CFP:
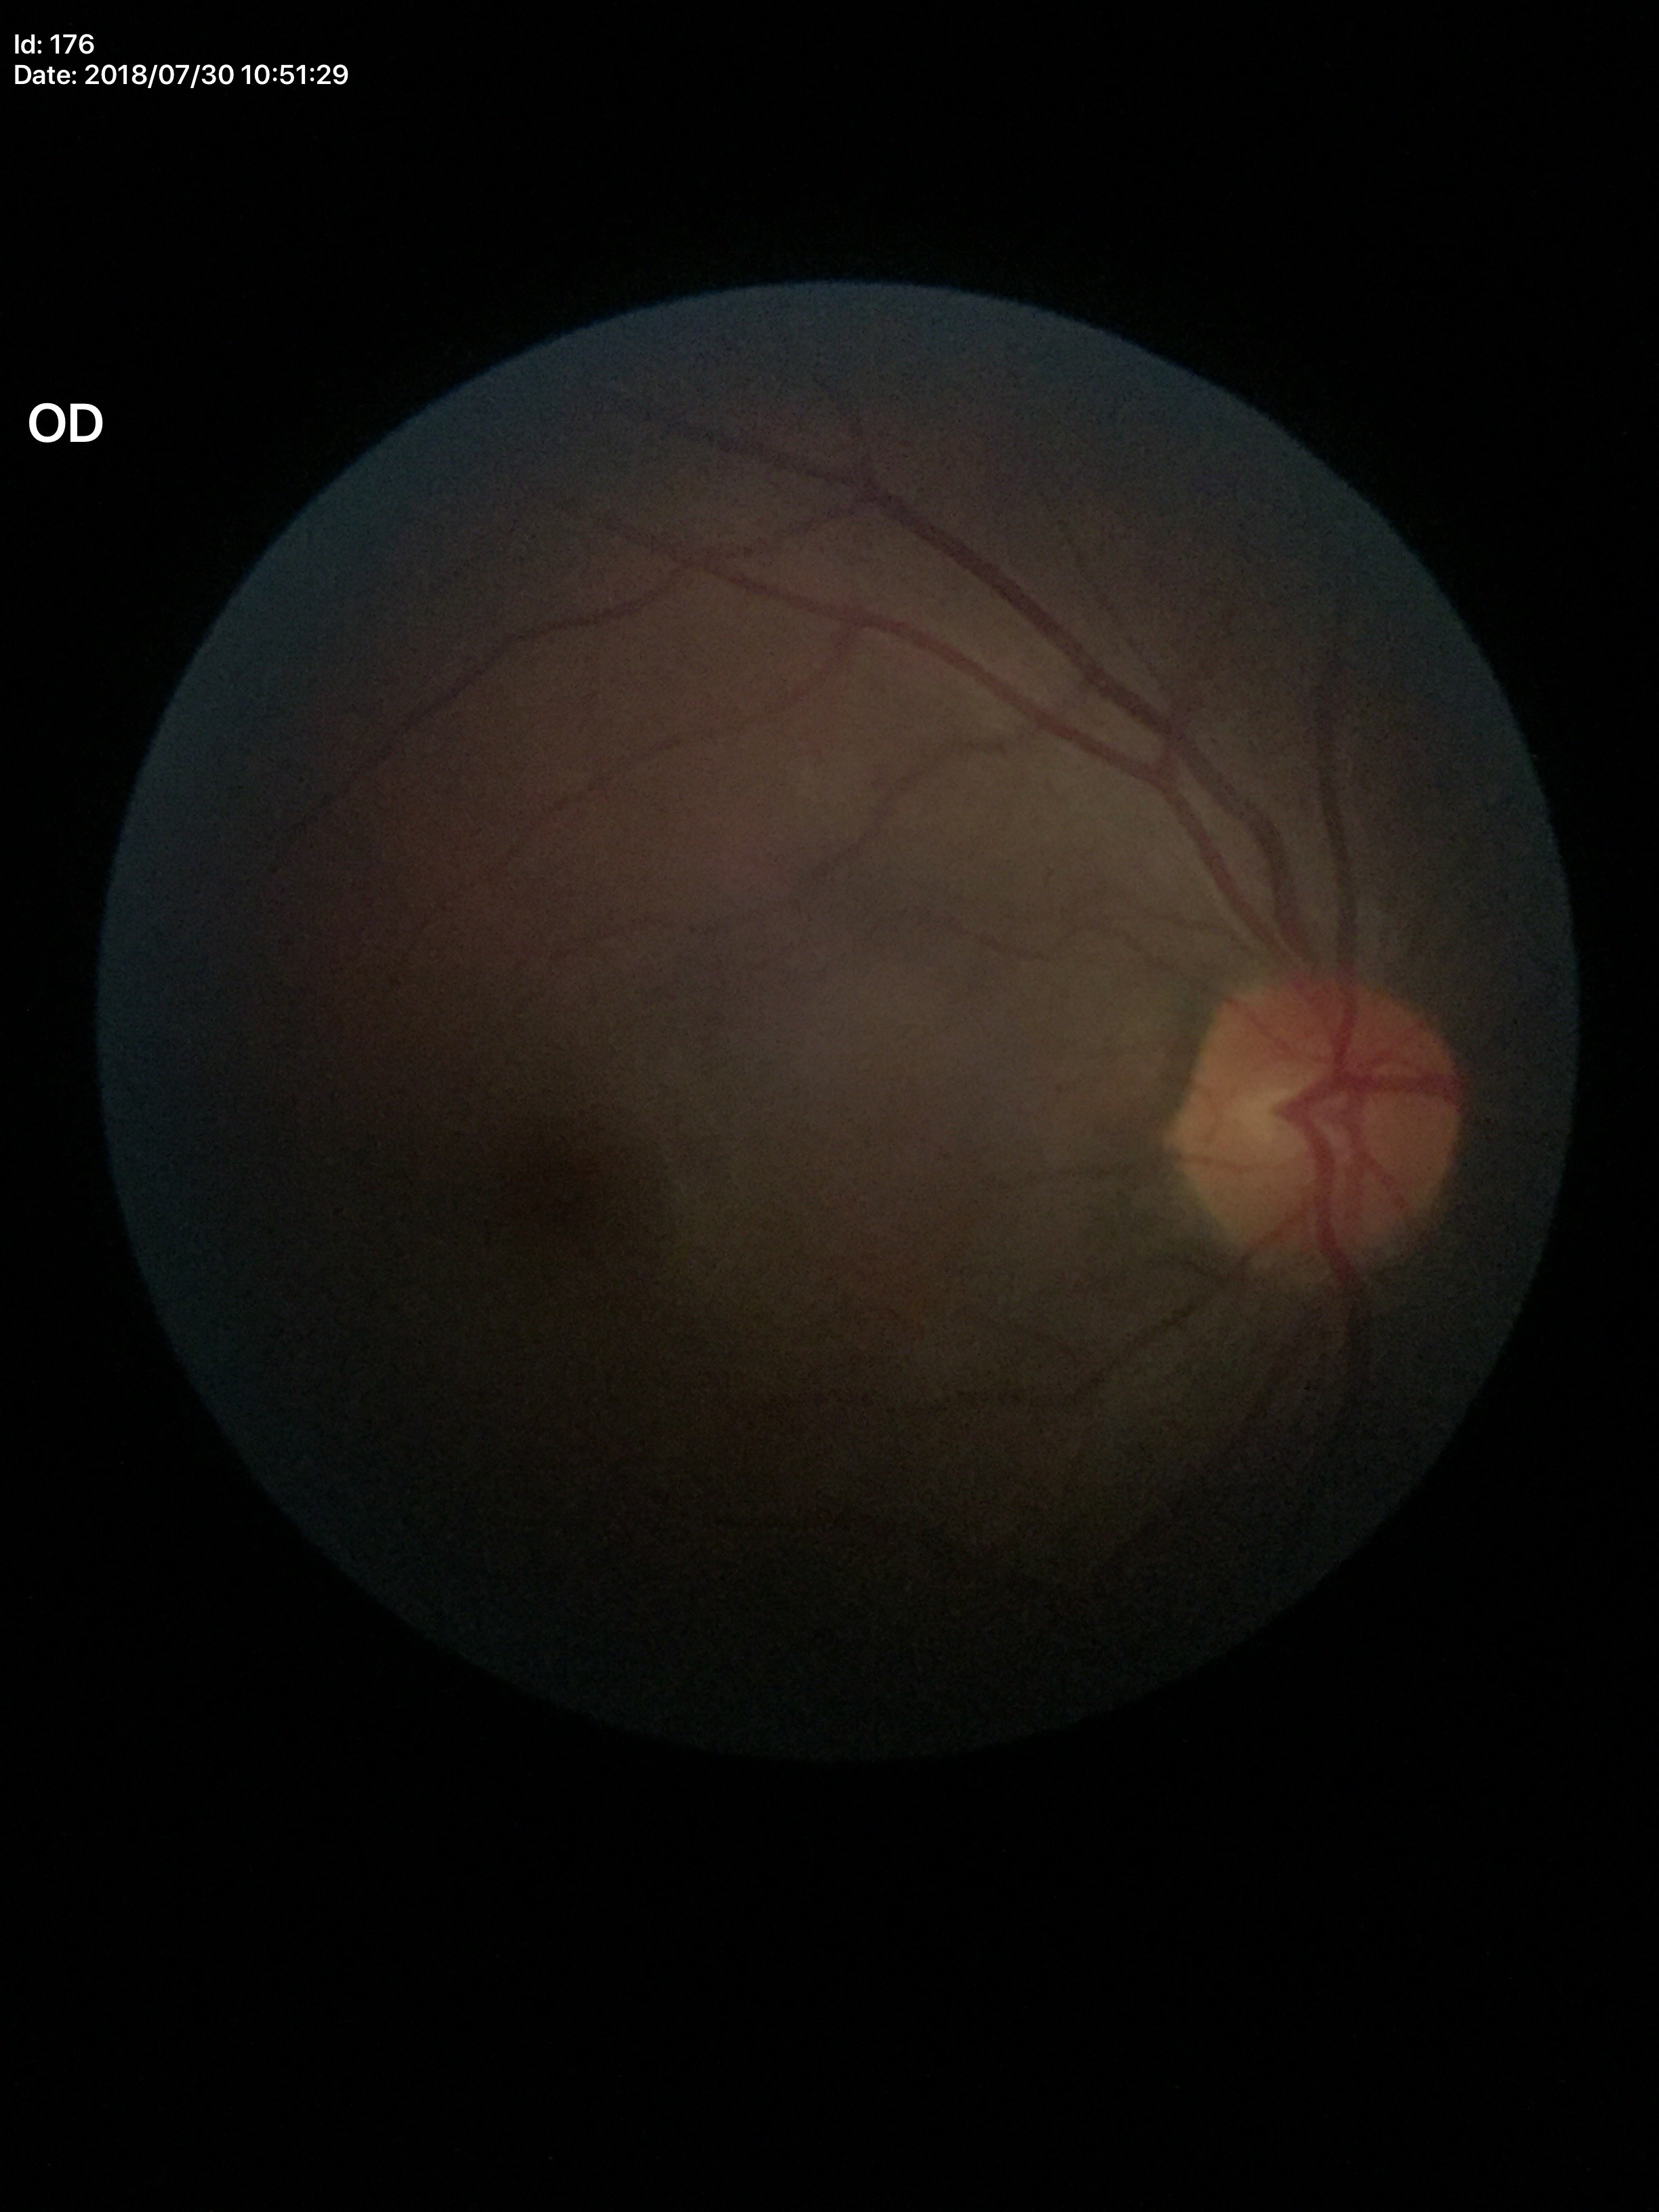
Annotations:
• Glaucoma screening — negative
• horizontal CDR — 0.52
• vertical cup-disc ratio — 0.46